Wide-field fundus photograph from neonatal ROP screening — 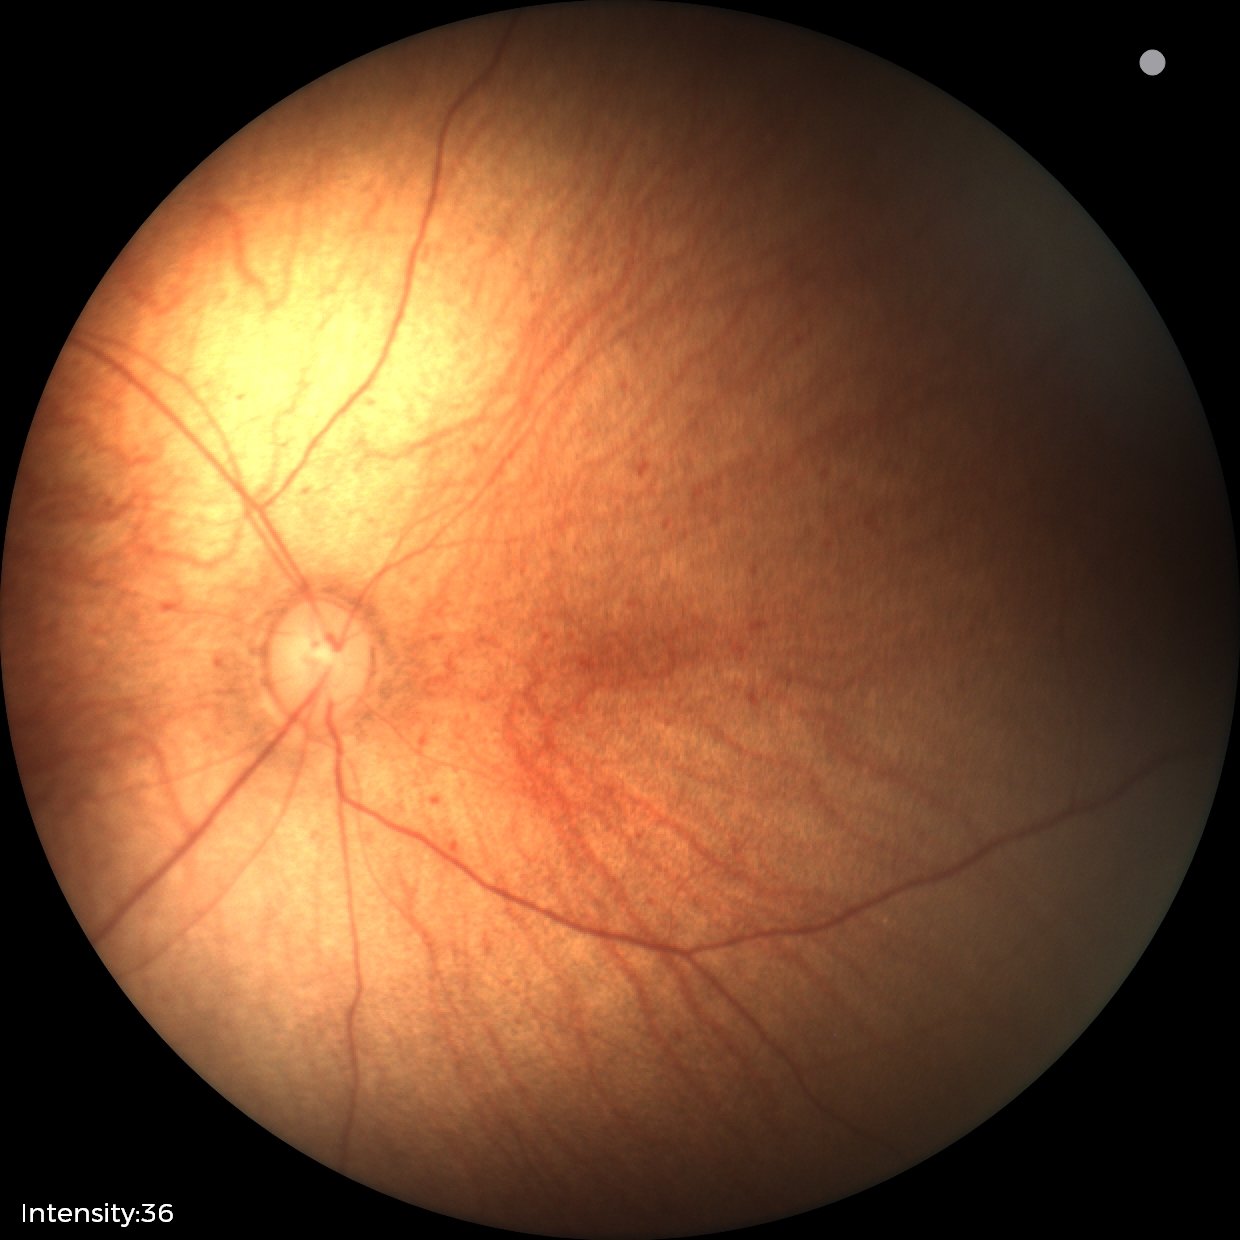
Examination with physiological retinal findings.